1380x1382; color fundus photograph; 45-degree field of view — 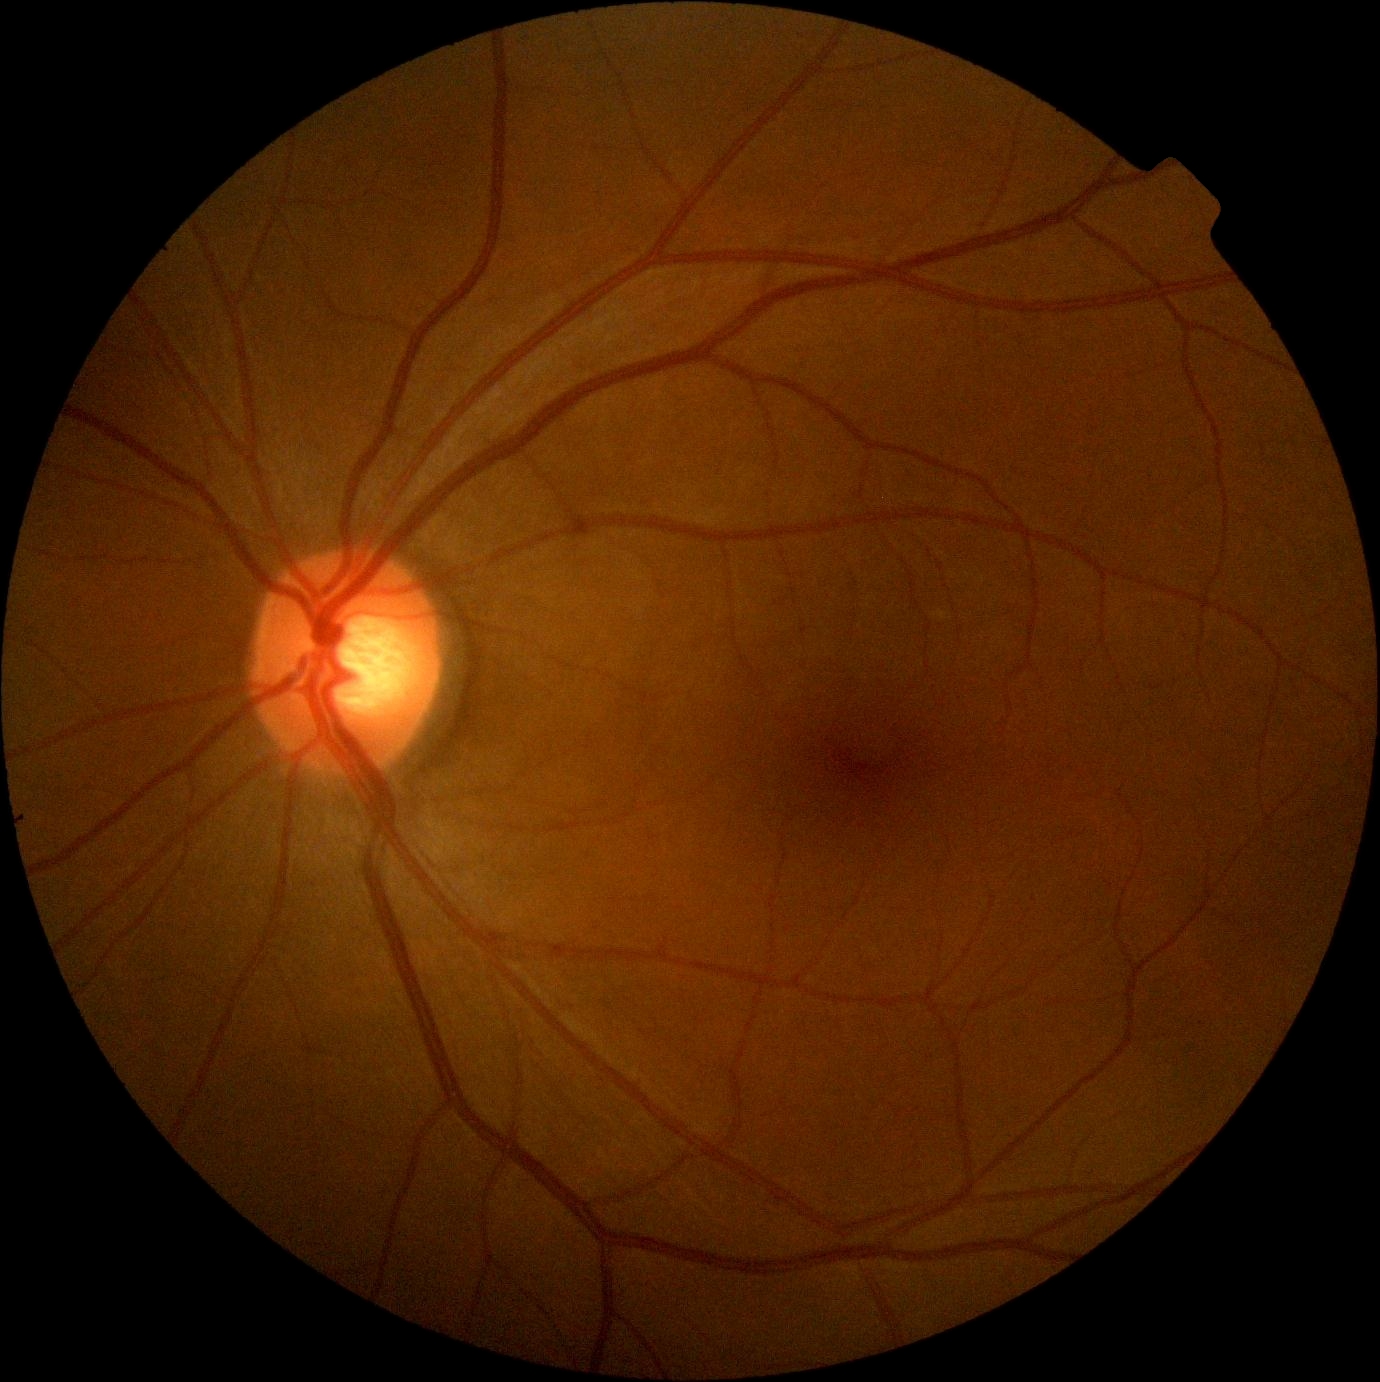 DR@grade 0.